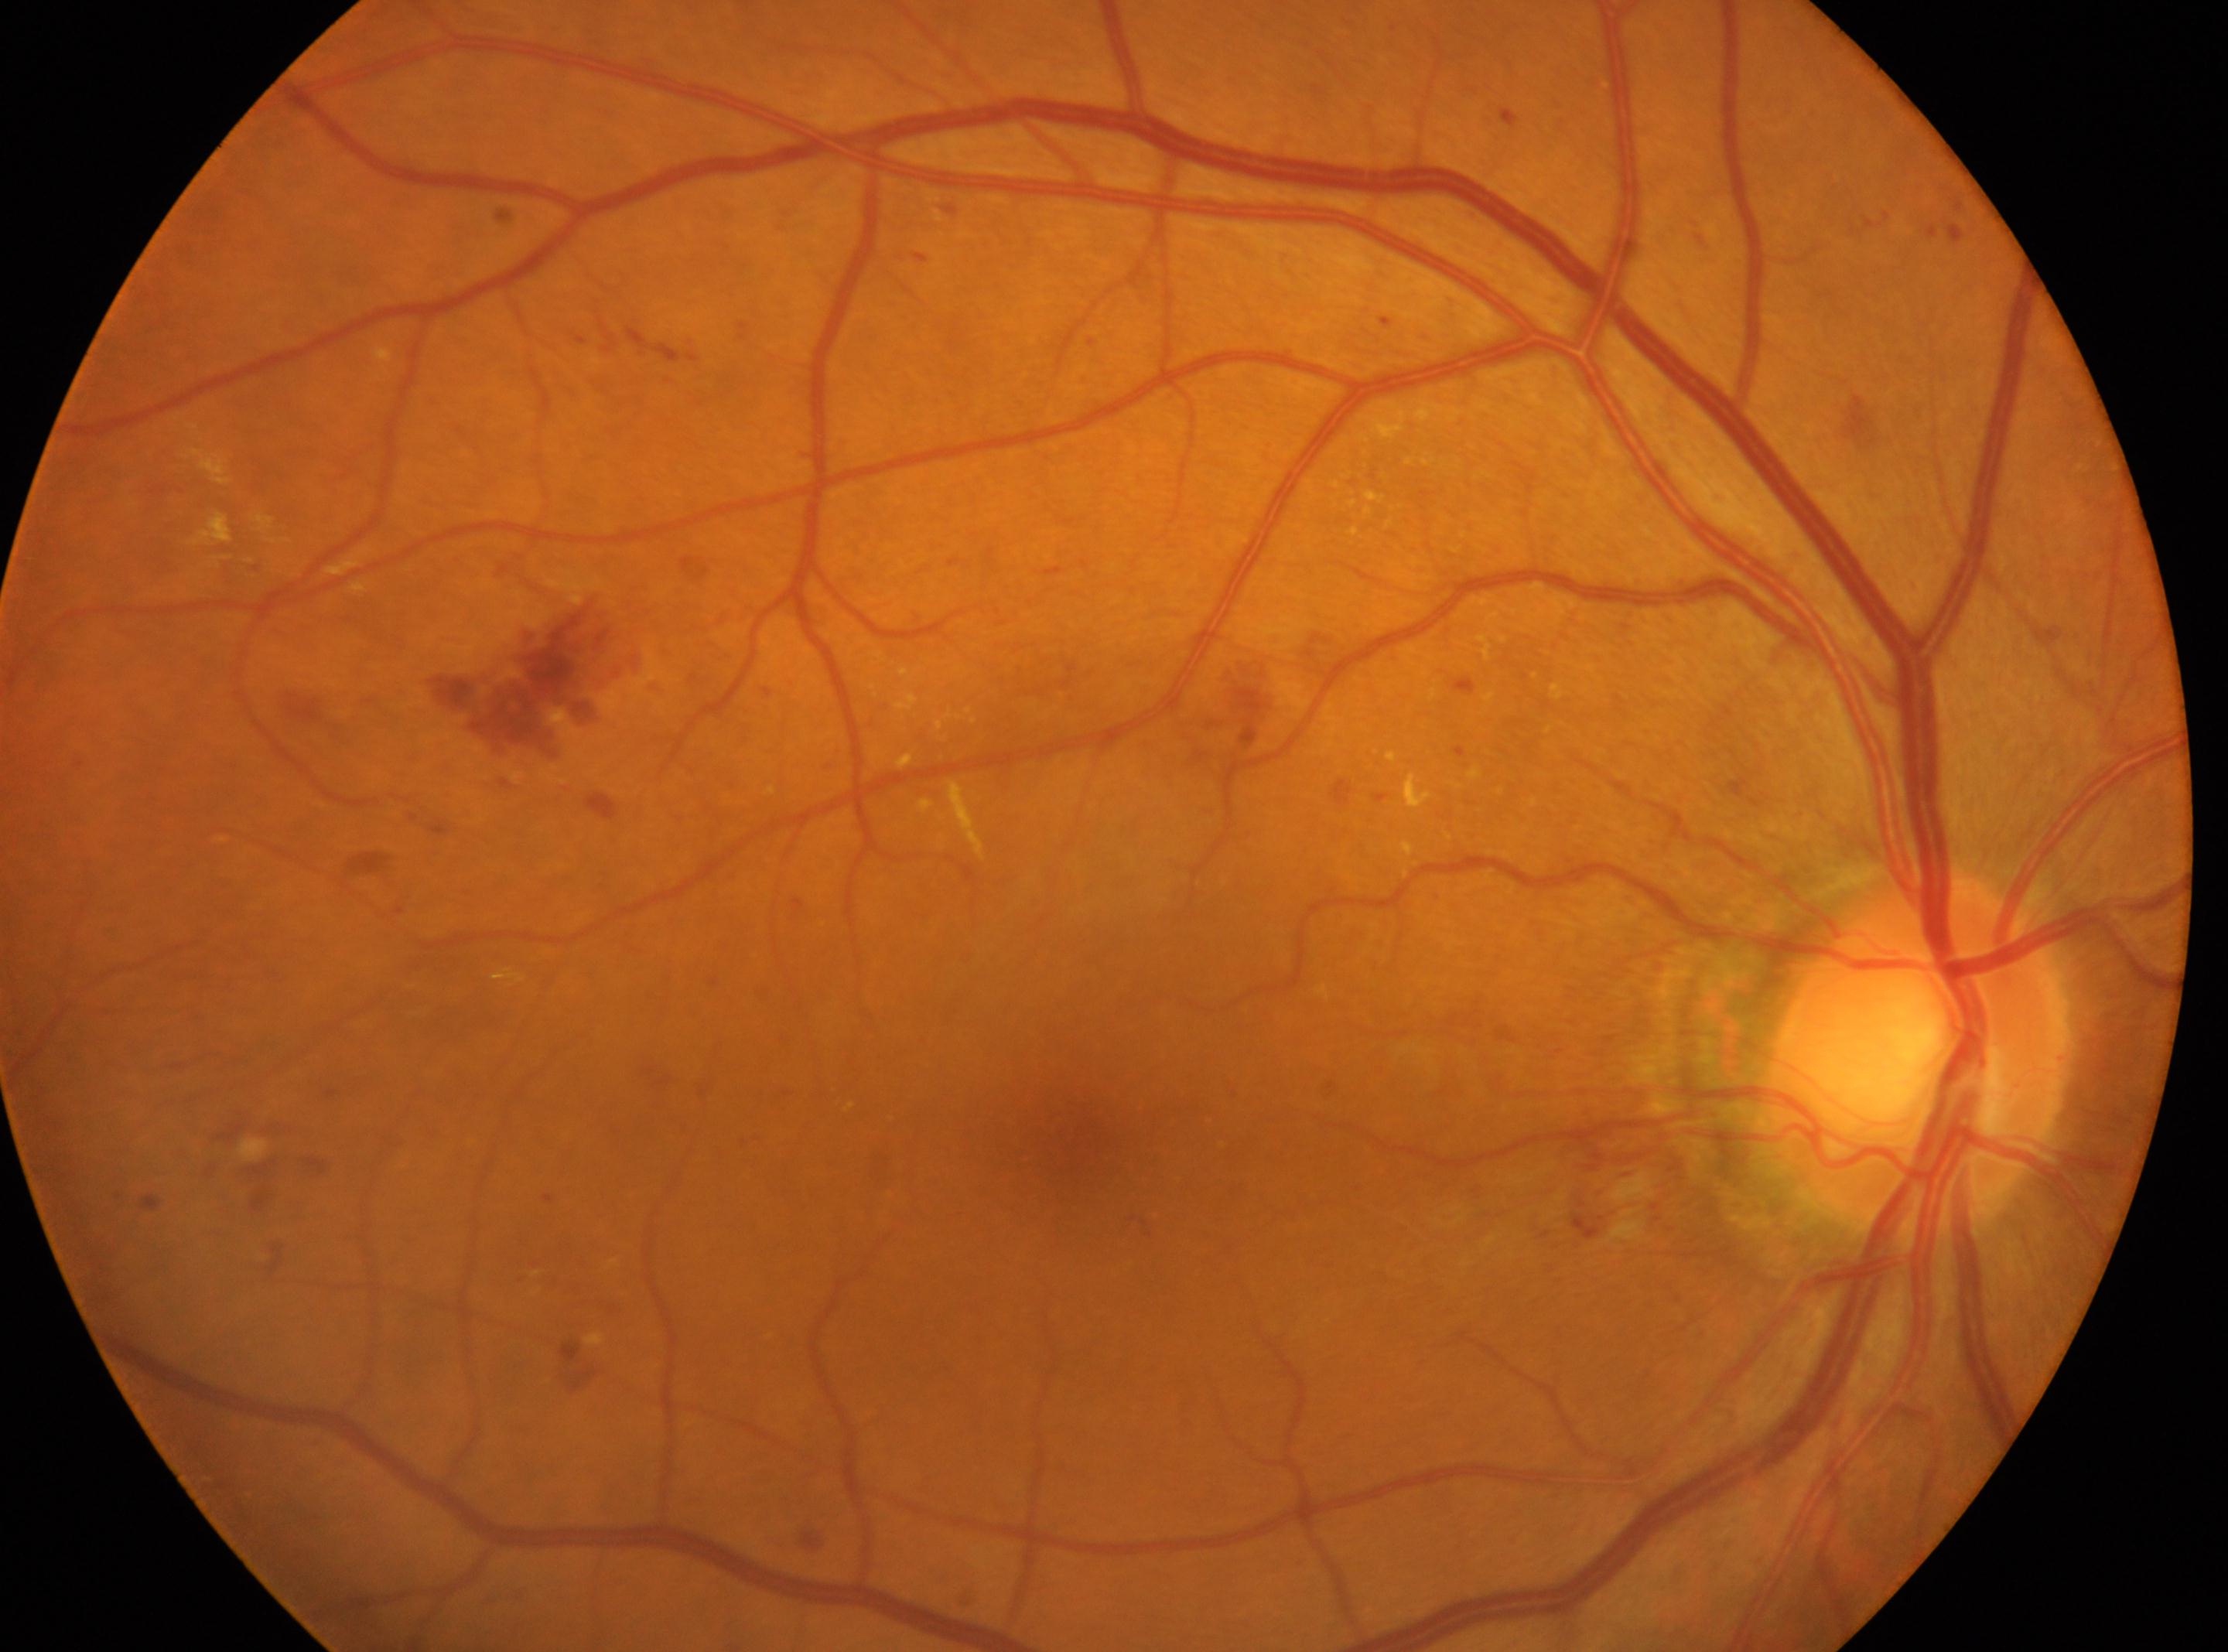 {
  "fovea": "(1077,1137)",
  "dr_grade": "2 (moderate NPDR)",
  "optic_disc": "(1917,1053)",
  "eye": "oculus dexter"
}